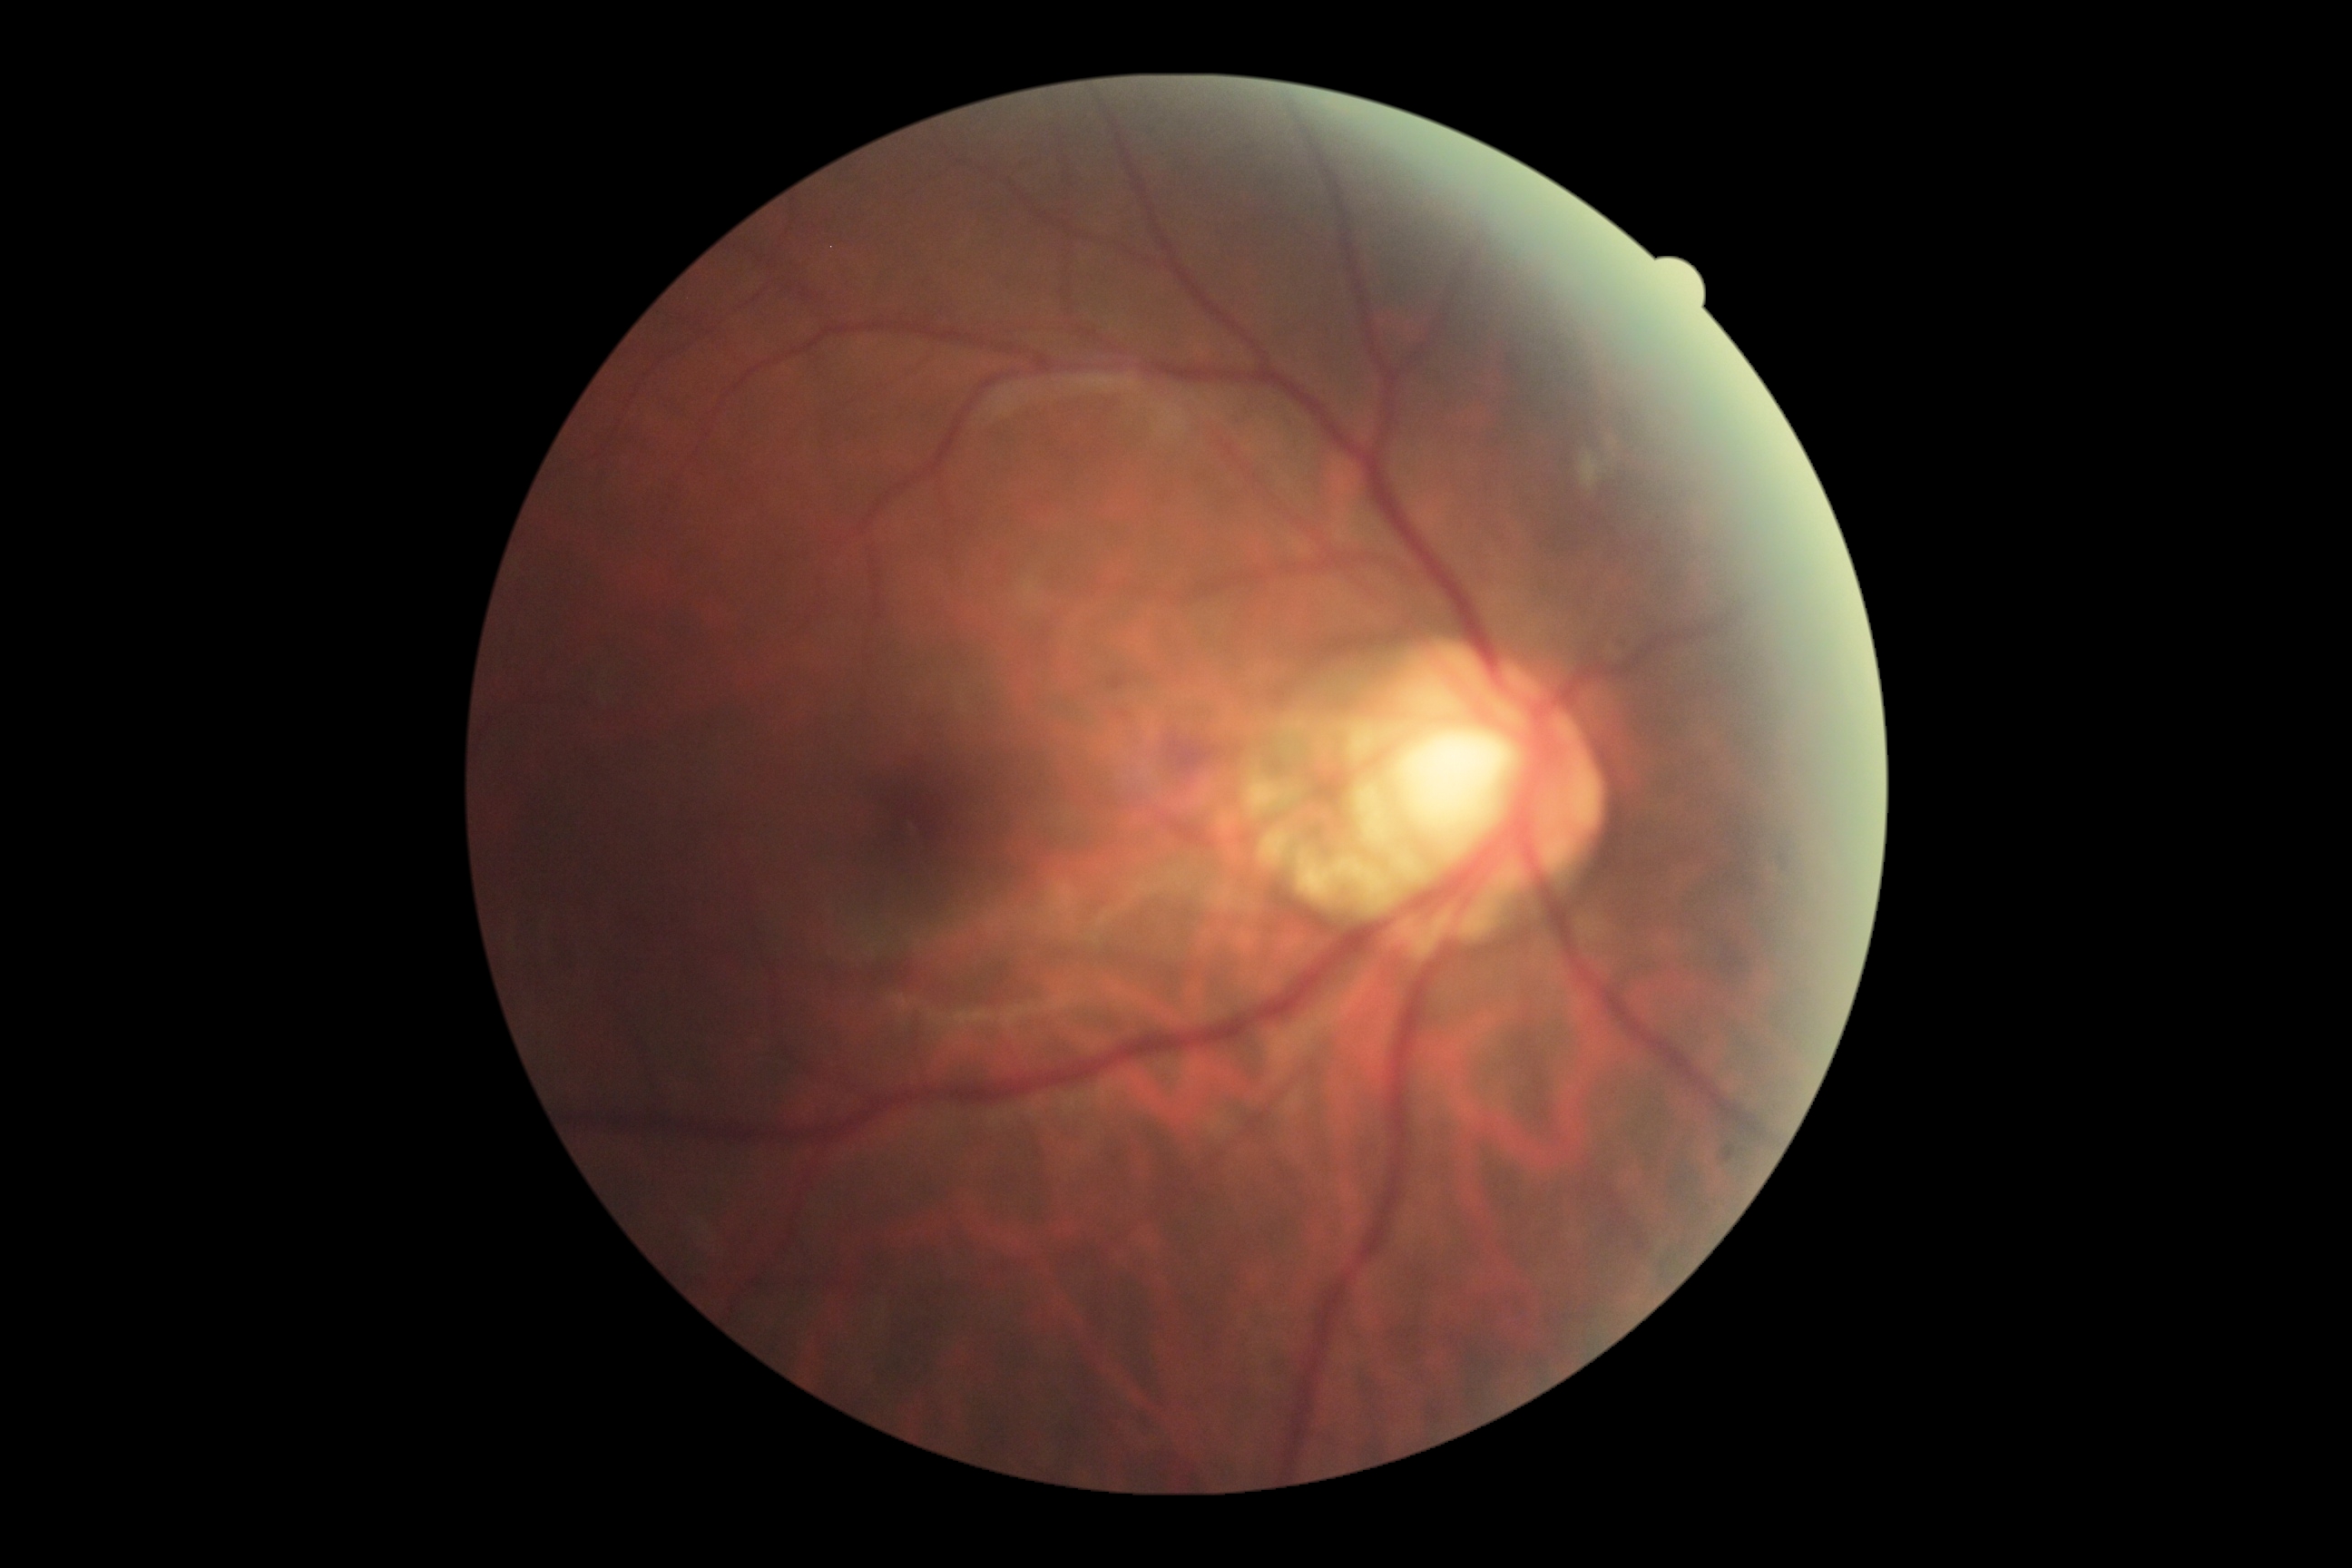 Diabetic retinopathy (DR): grade 2 (moderate NPDR).